1240 by 1240 pixels. Acquired on the Phoenix ICON. Wide-field contact fundus photograph of an infant:
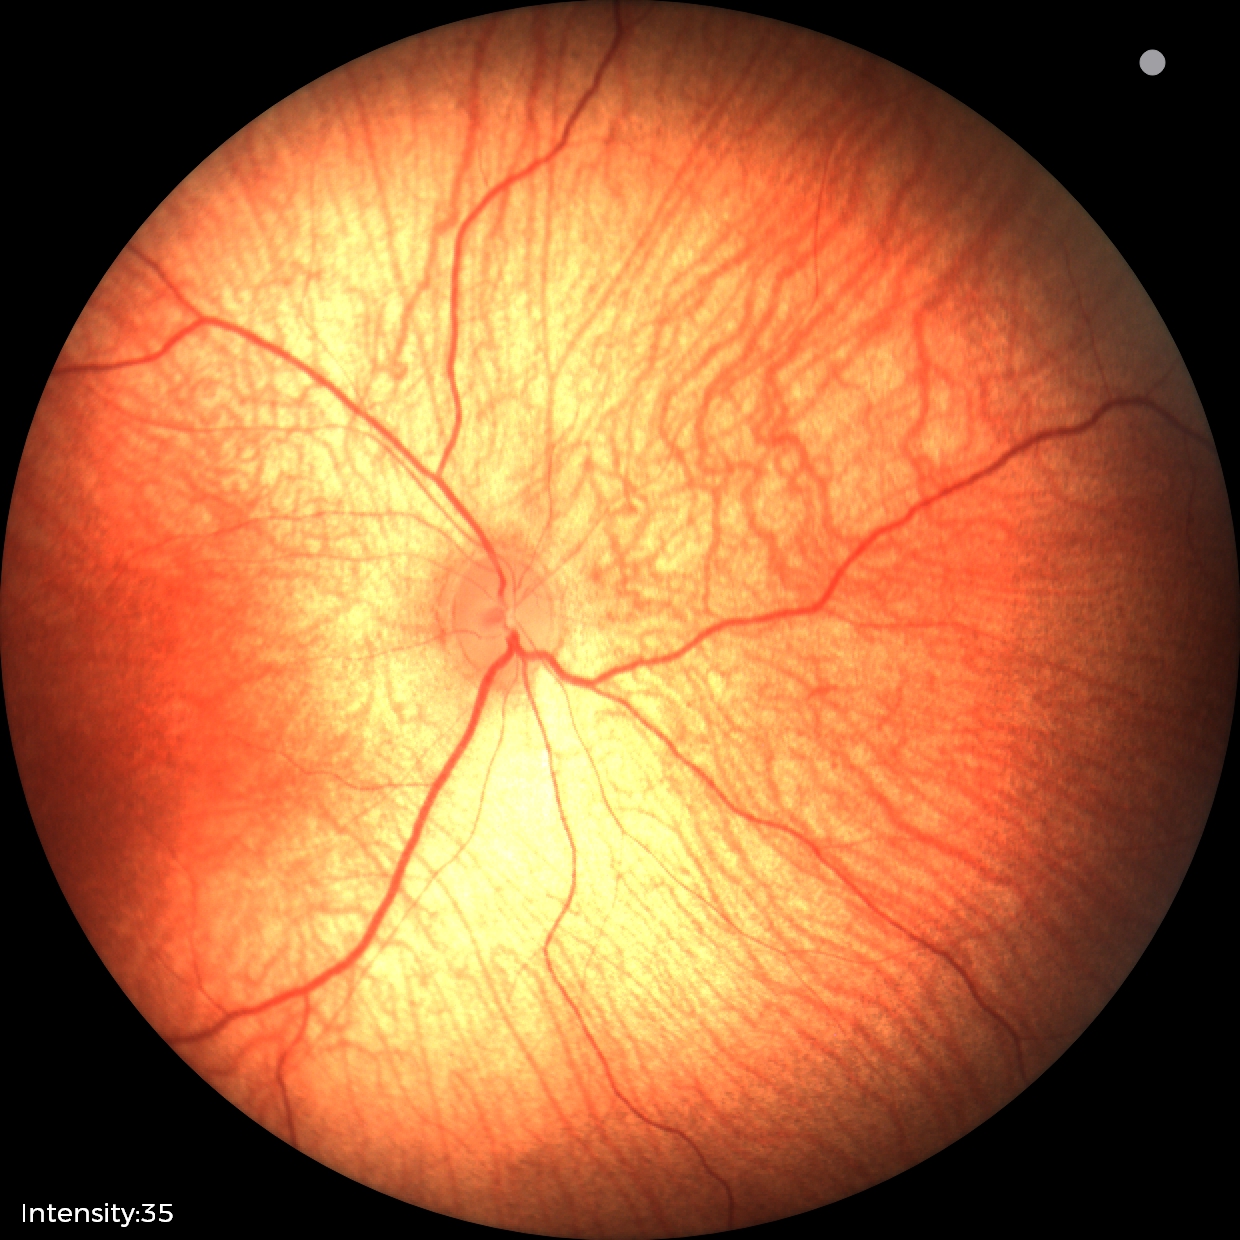

Screening examination with no abnormal retinal findings.